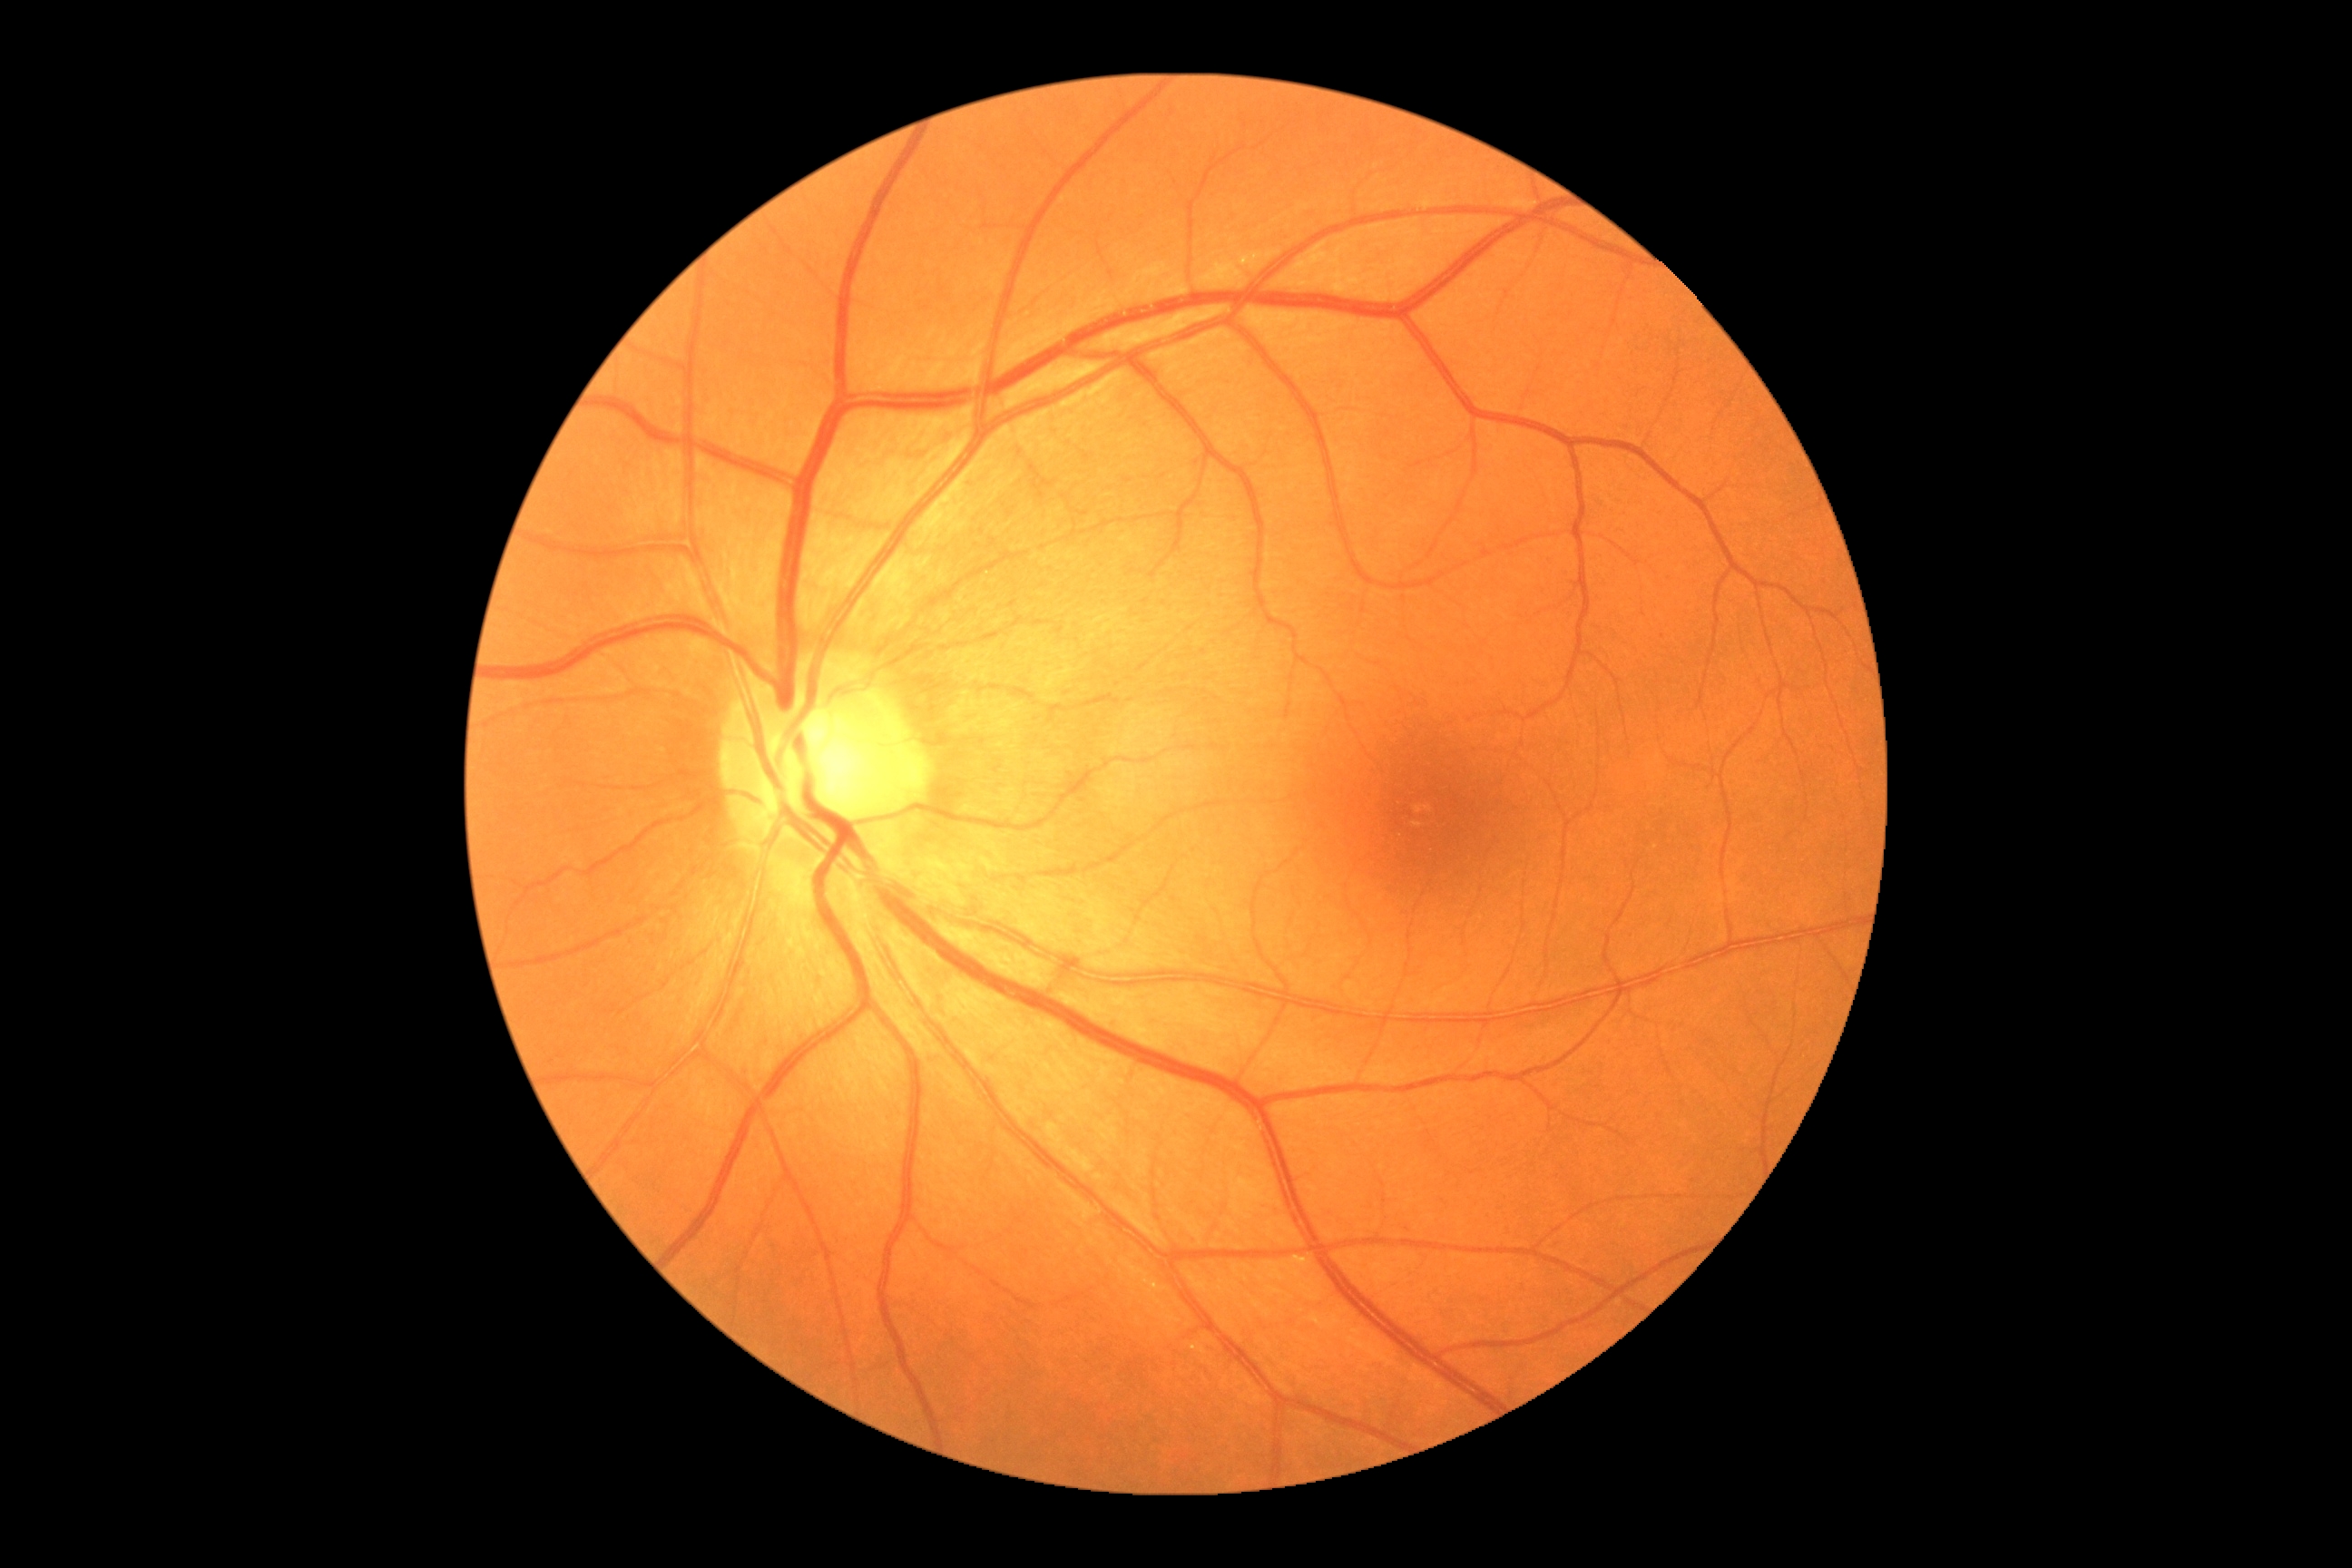
DR grade = 0 (no apparent retinopathy)
DR impression = no DR findings